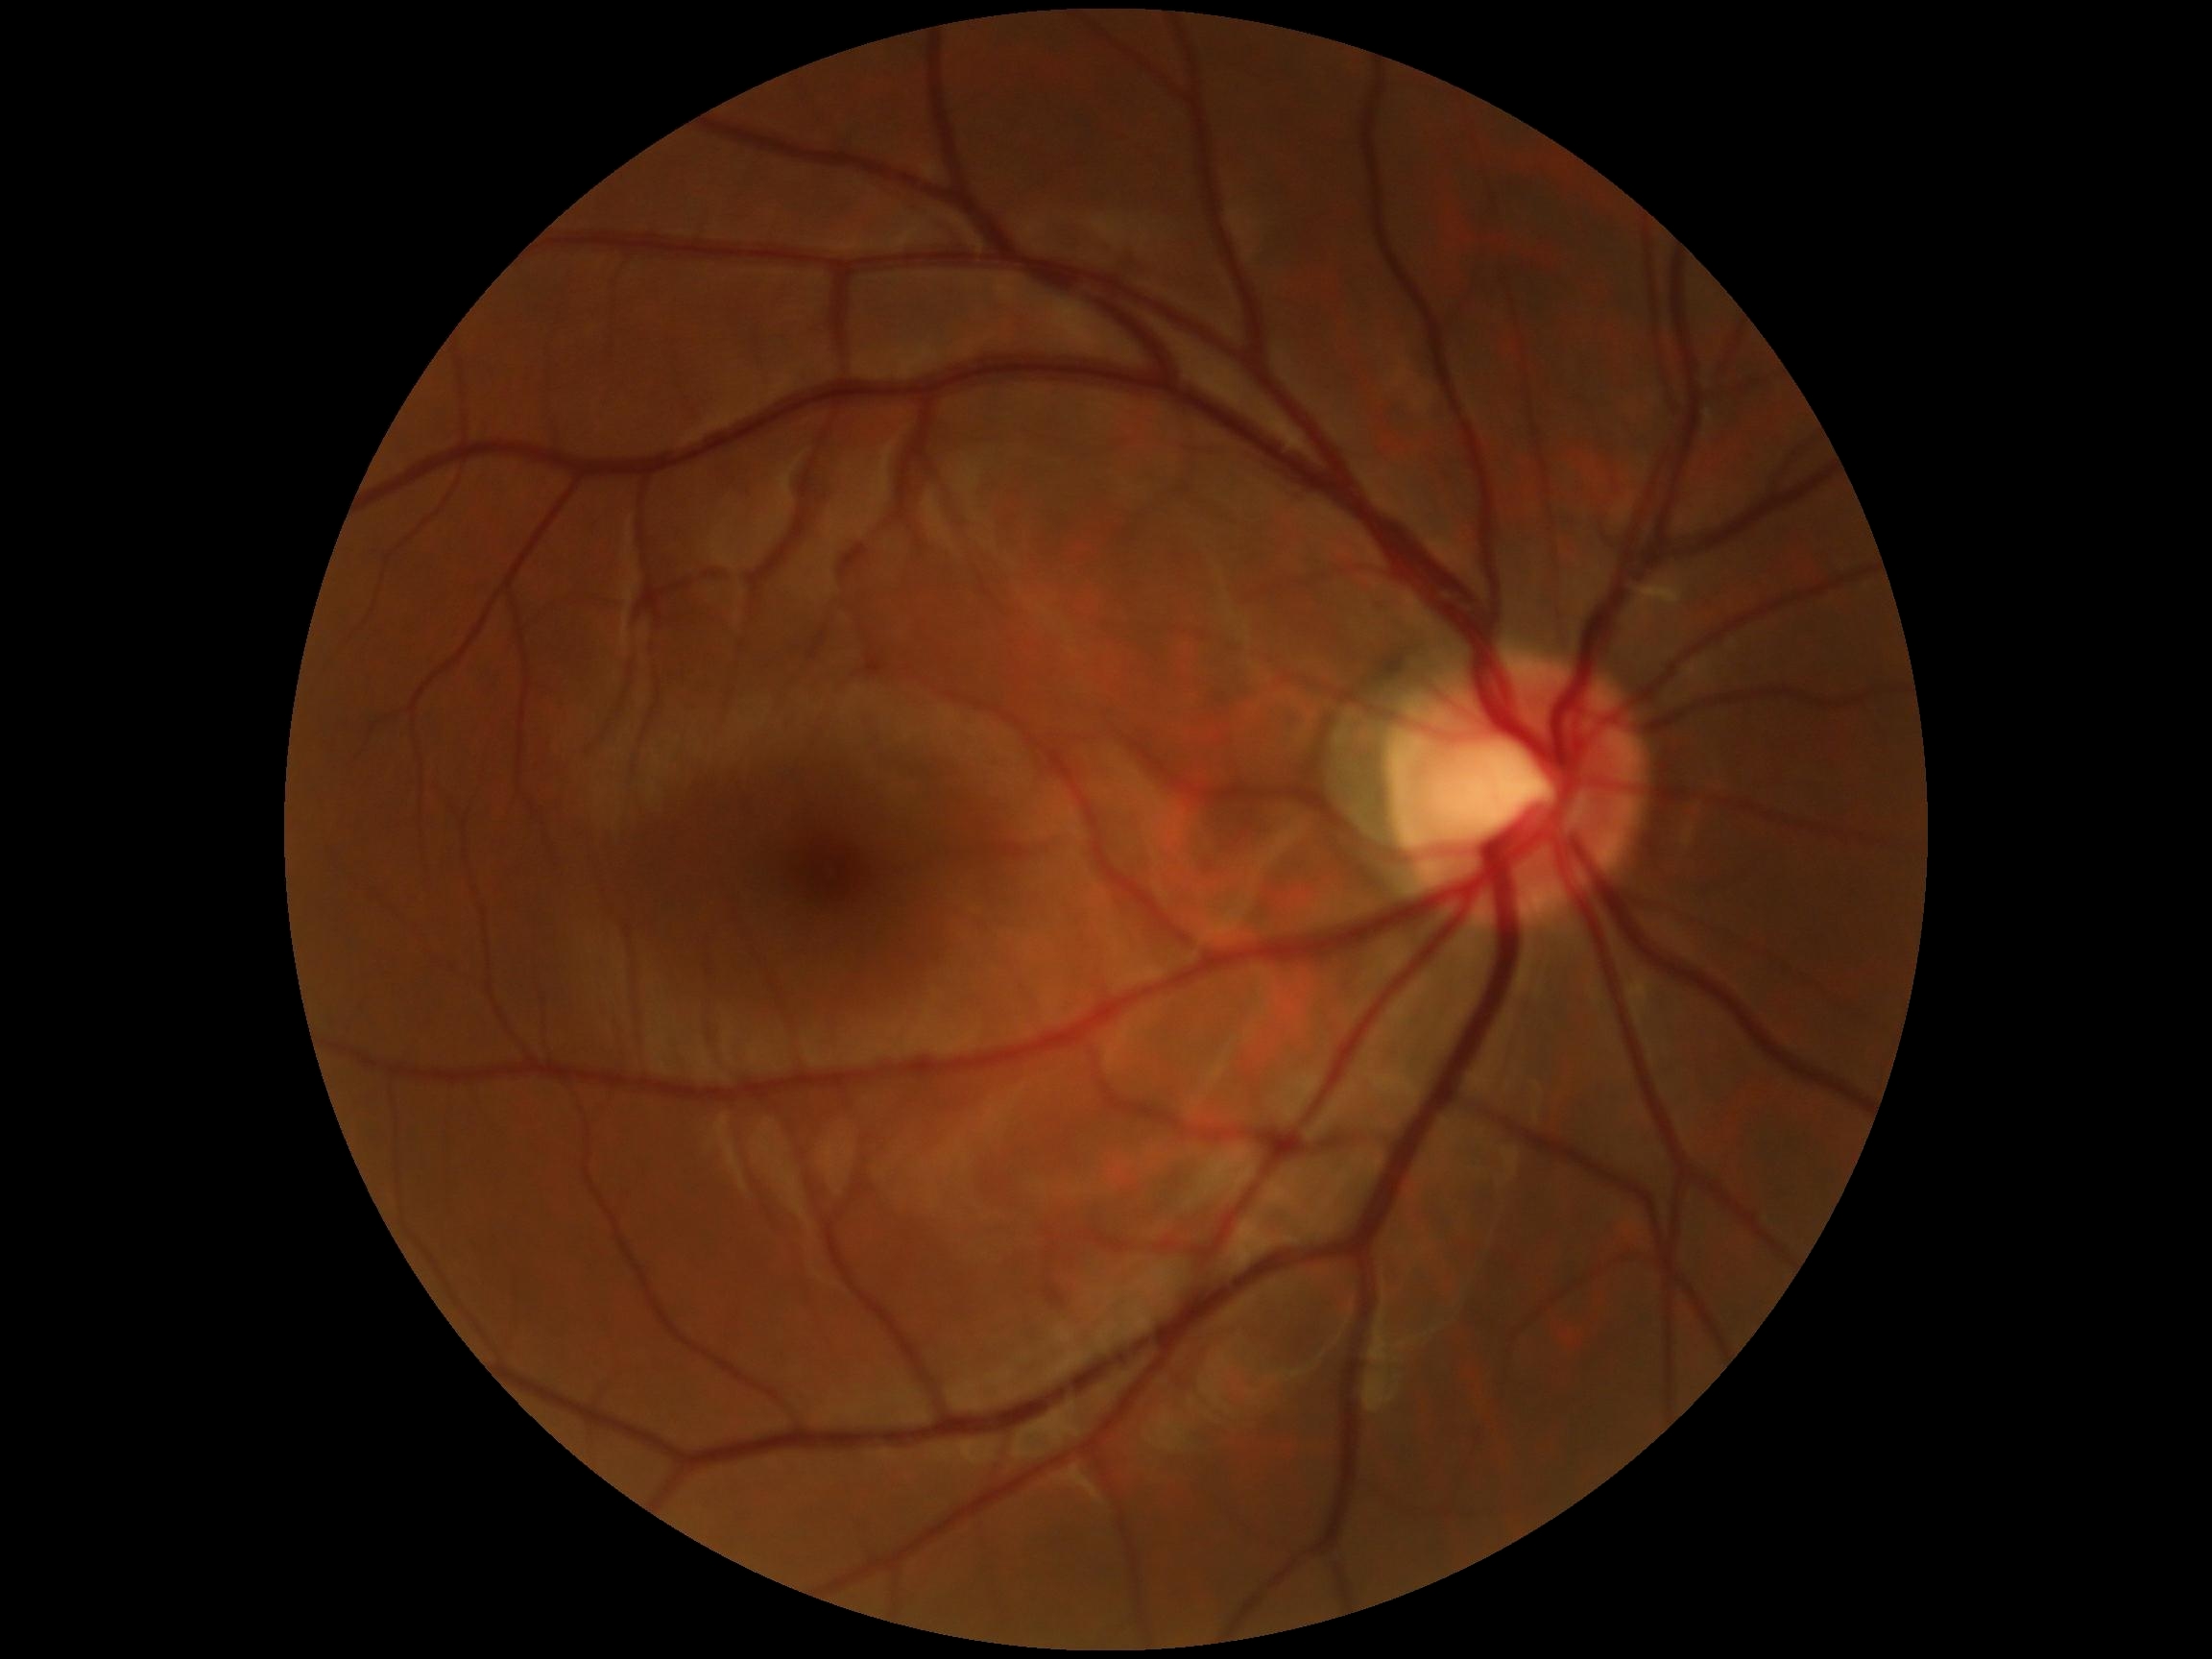 DR is grade 0 (no apparent retinopathy).